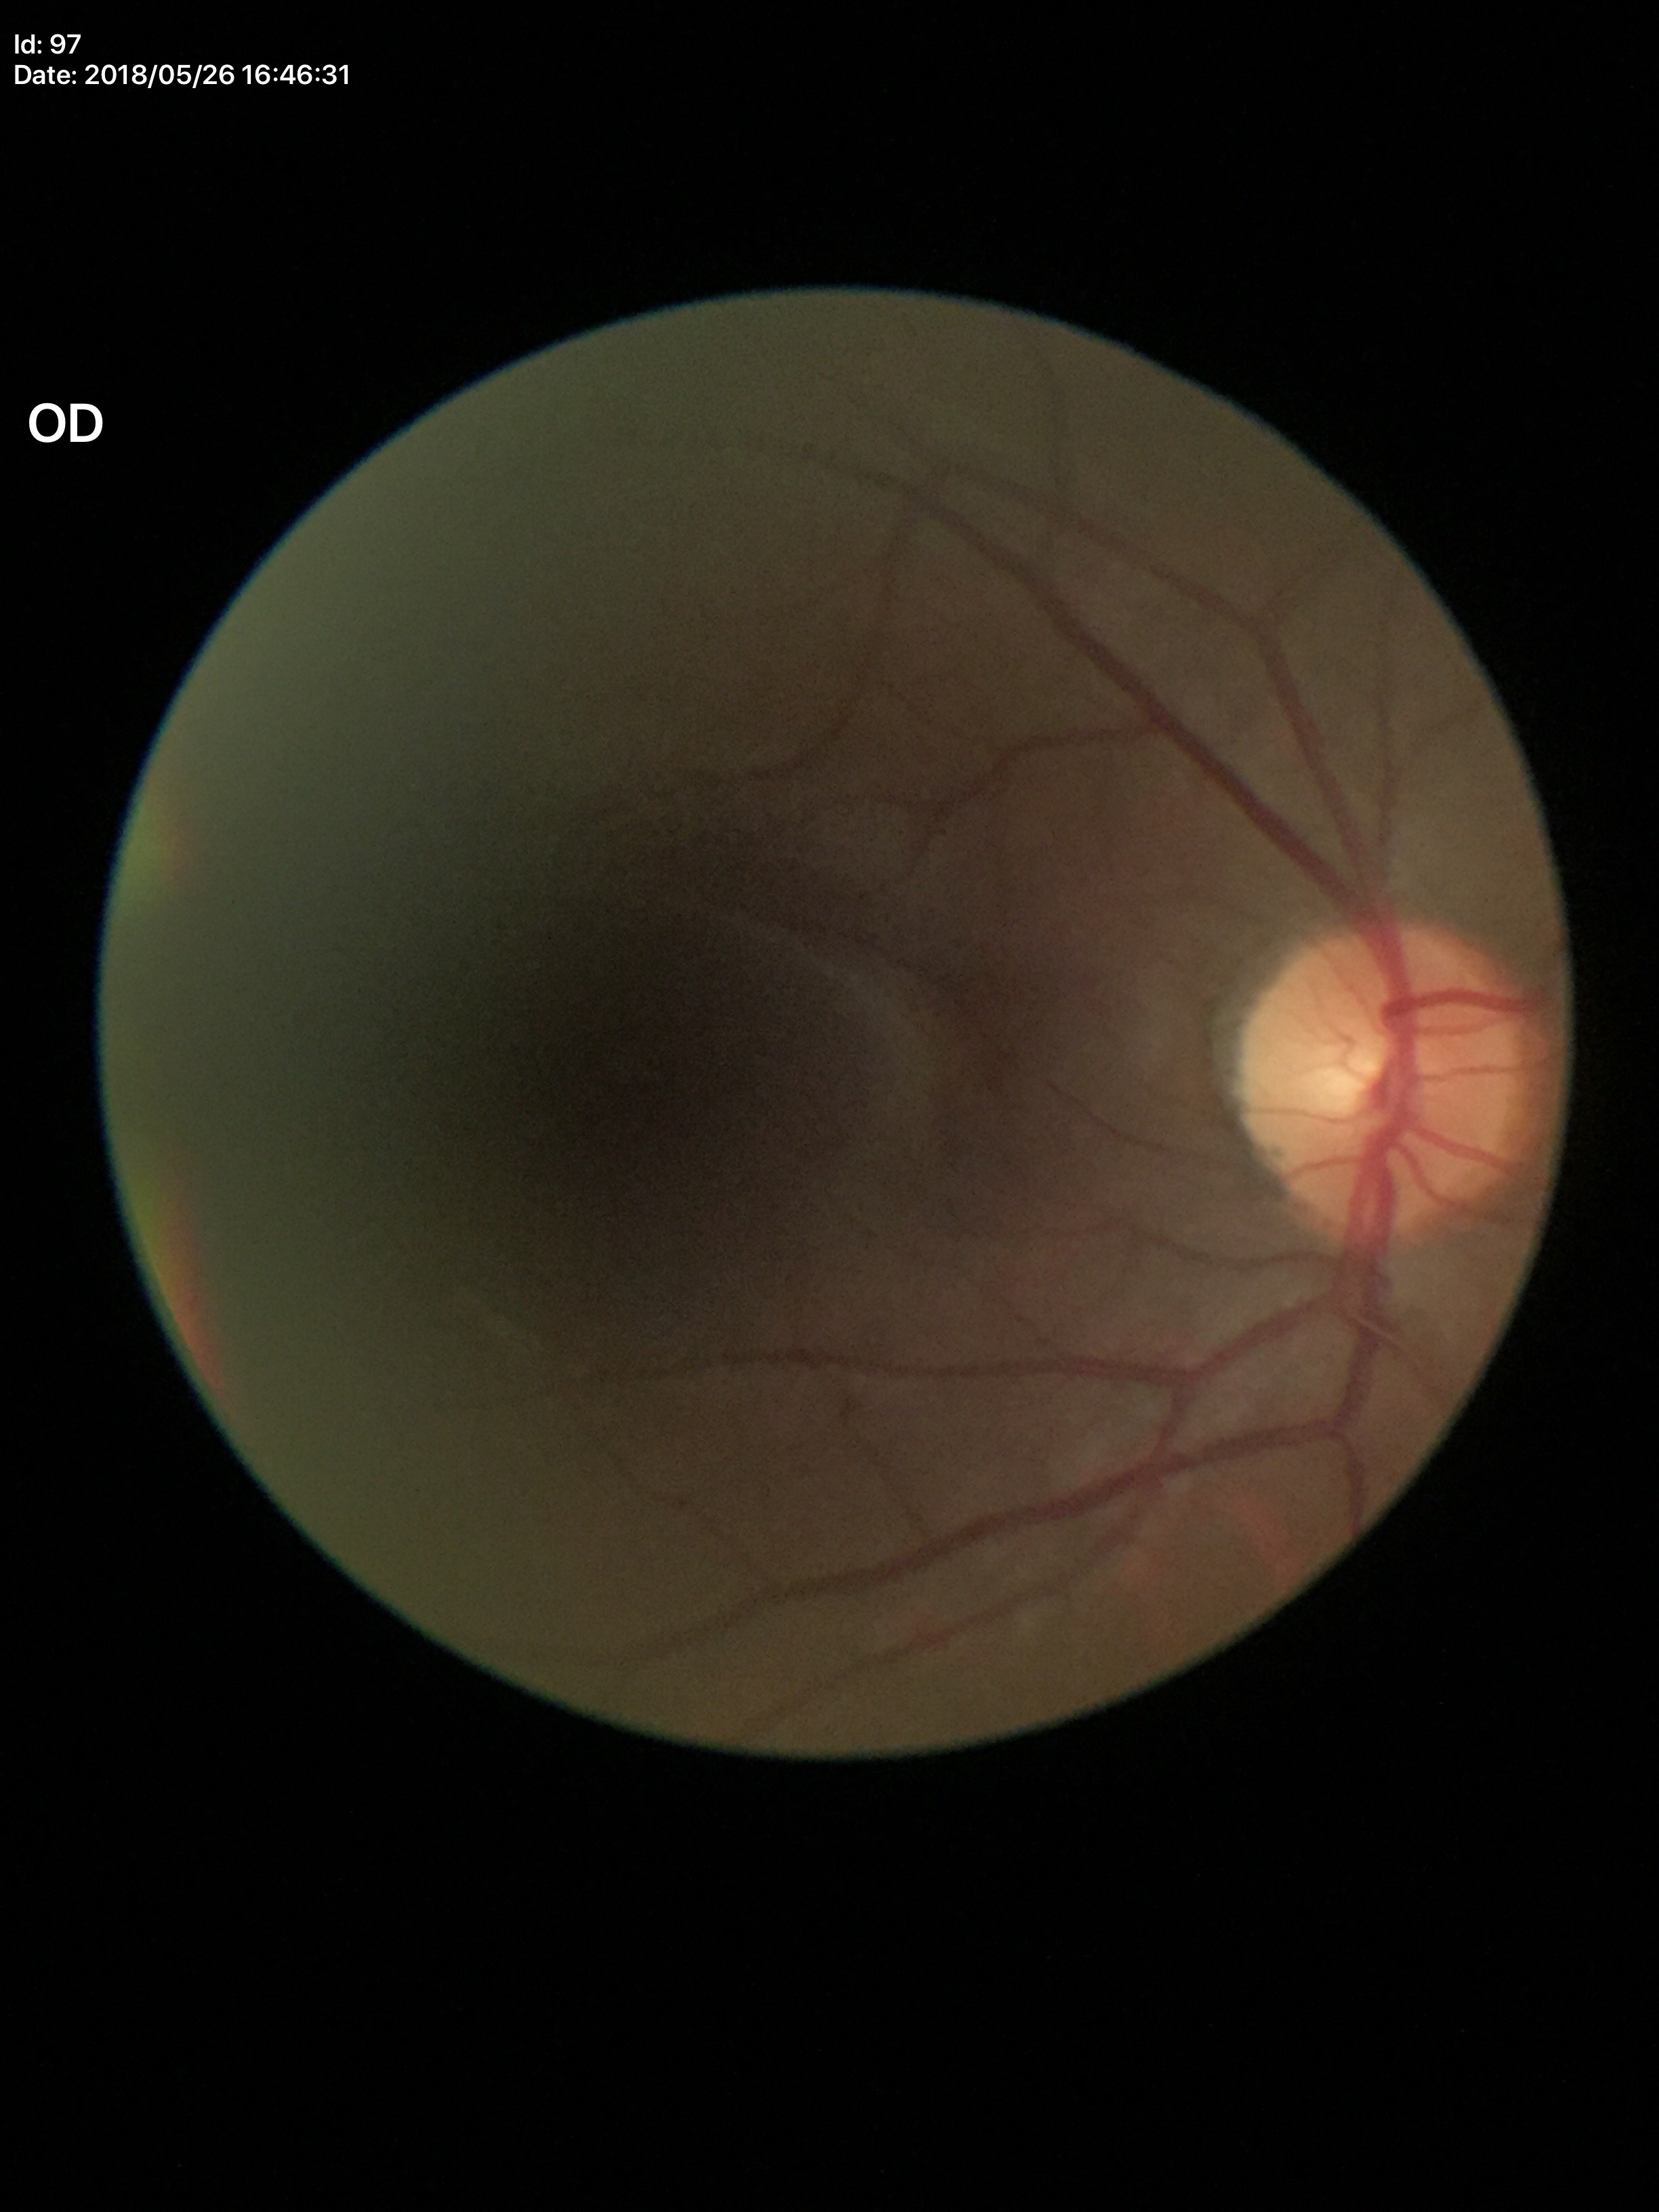

Glaucoma screening: not suspect.
Vertical cup-disc ratio (VCDR) is 0.48.